CFP: 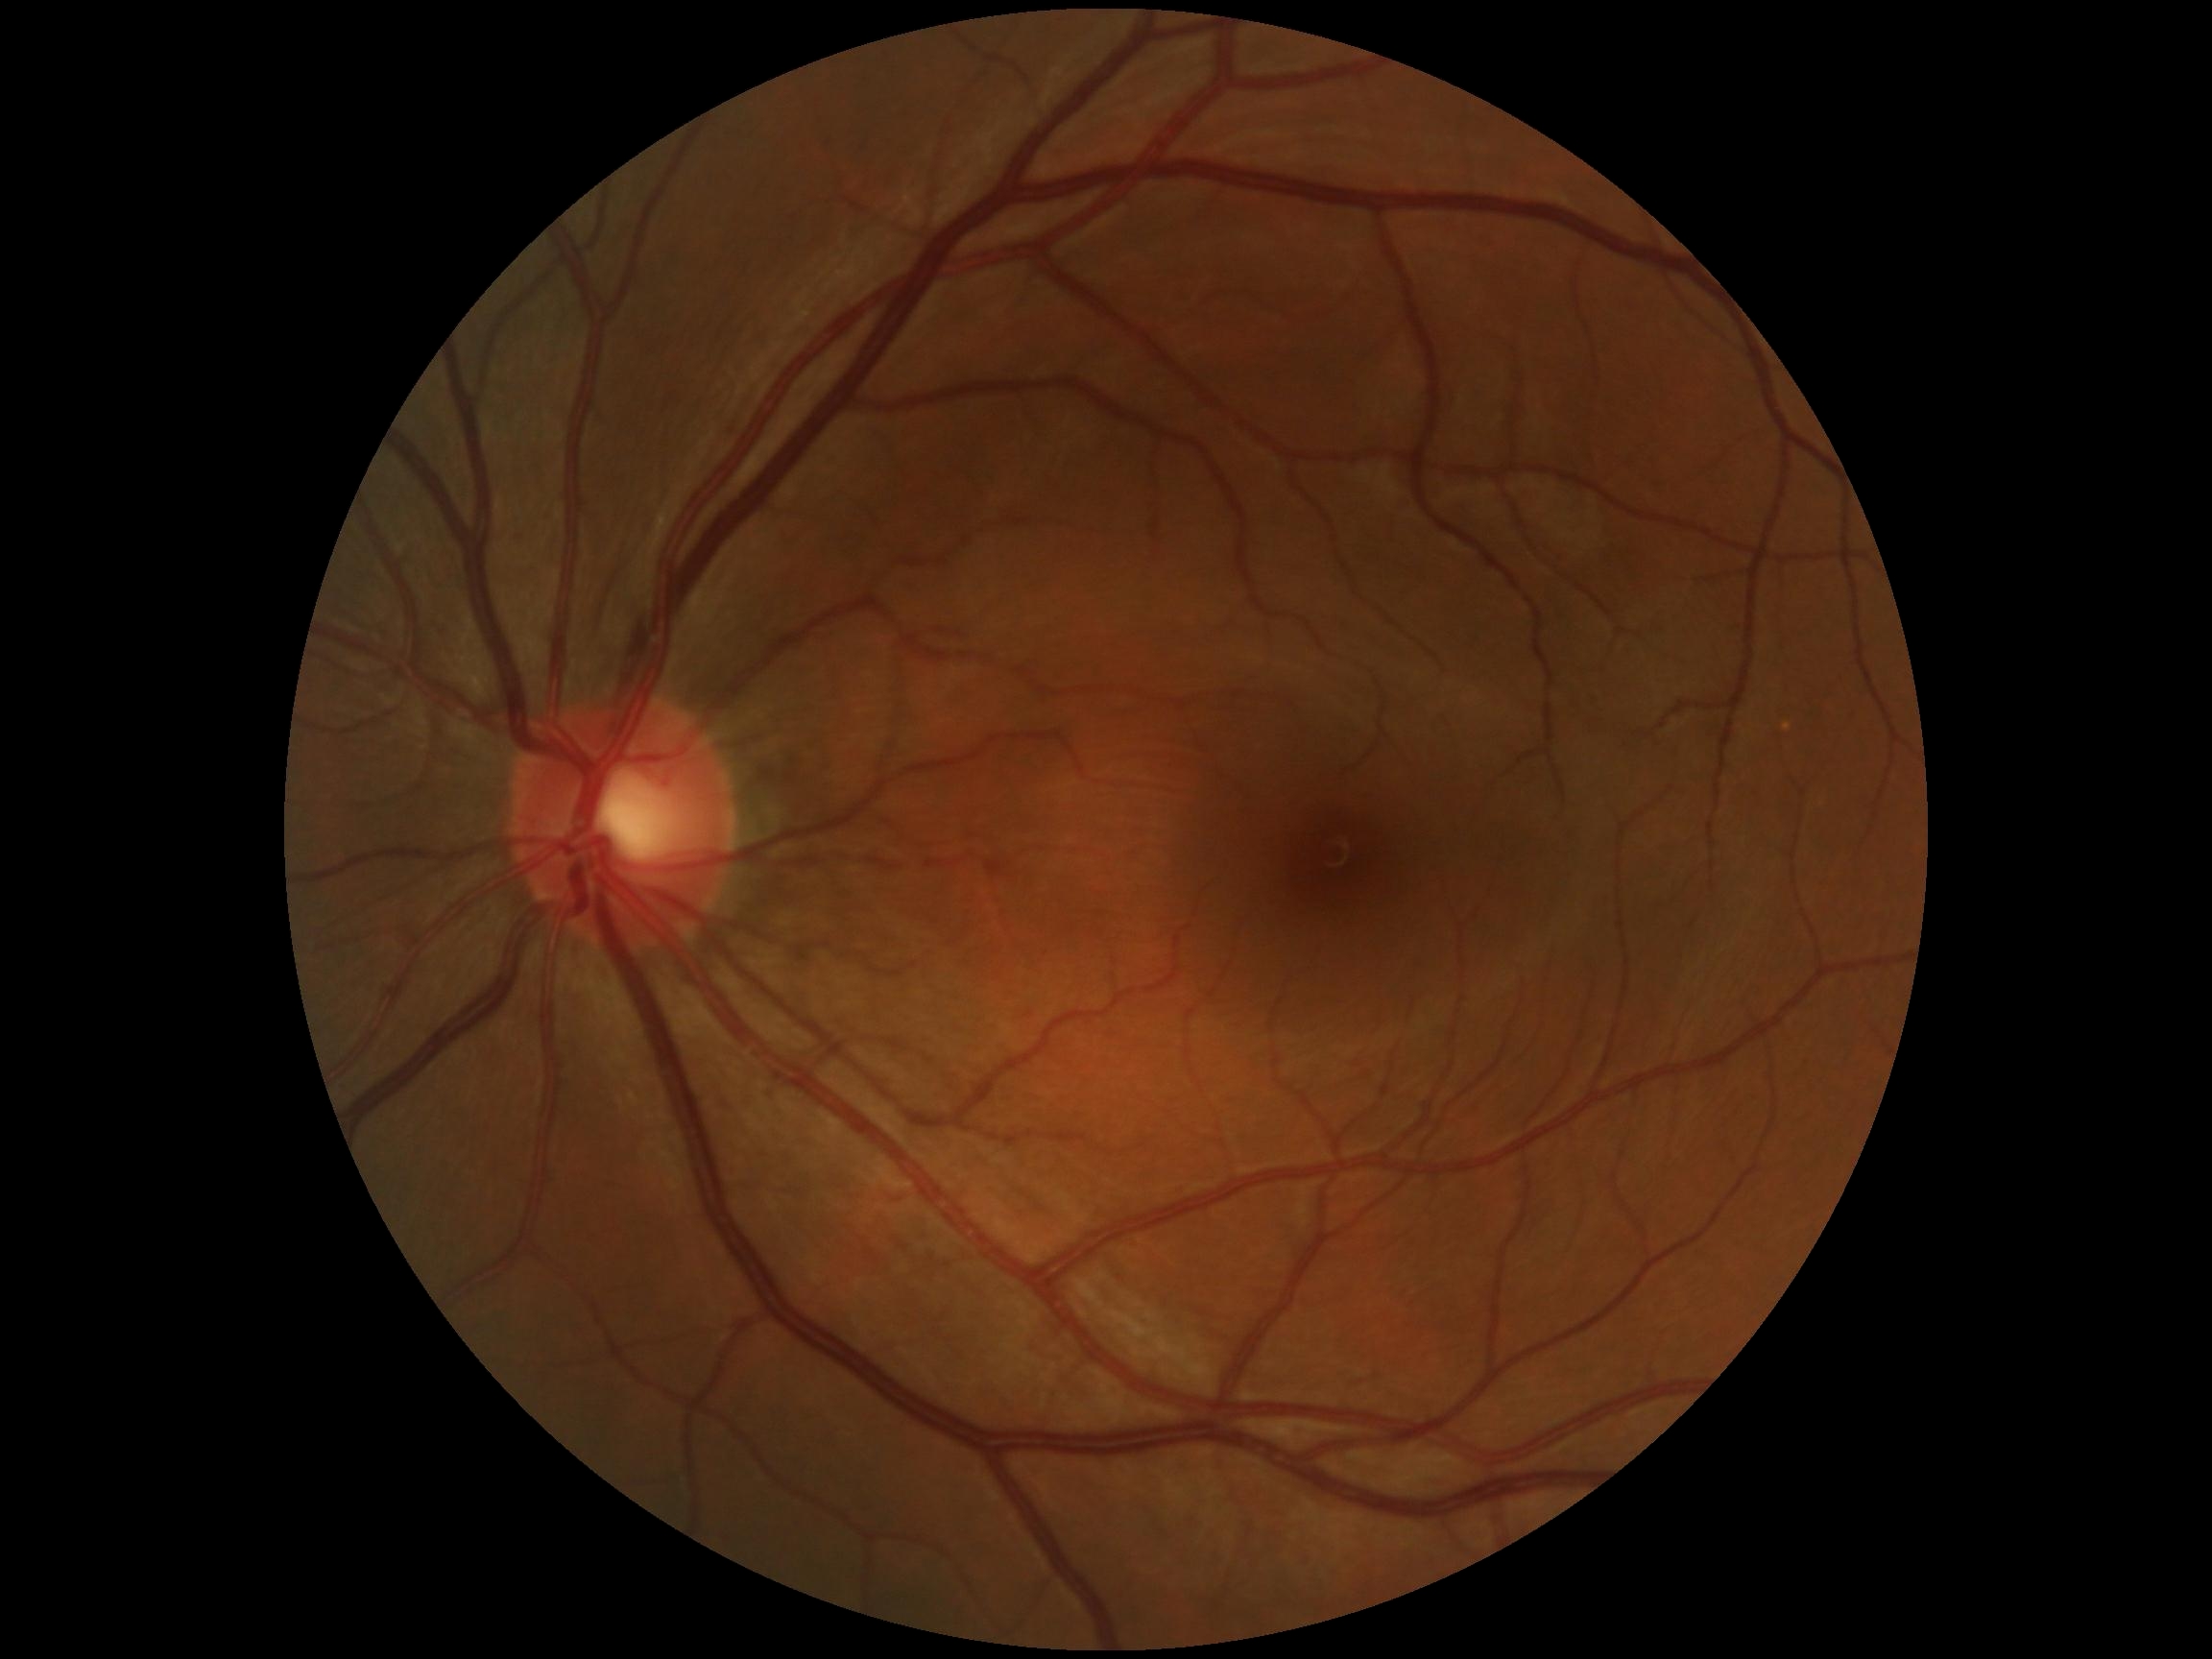   dr_grade: no apparent retinopathy (grade 0)